2352 x 1568 pixels: 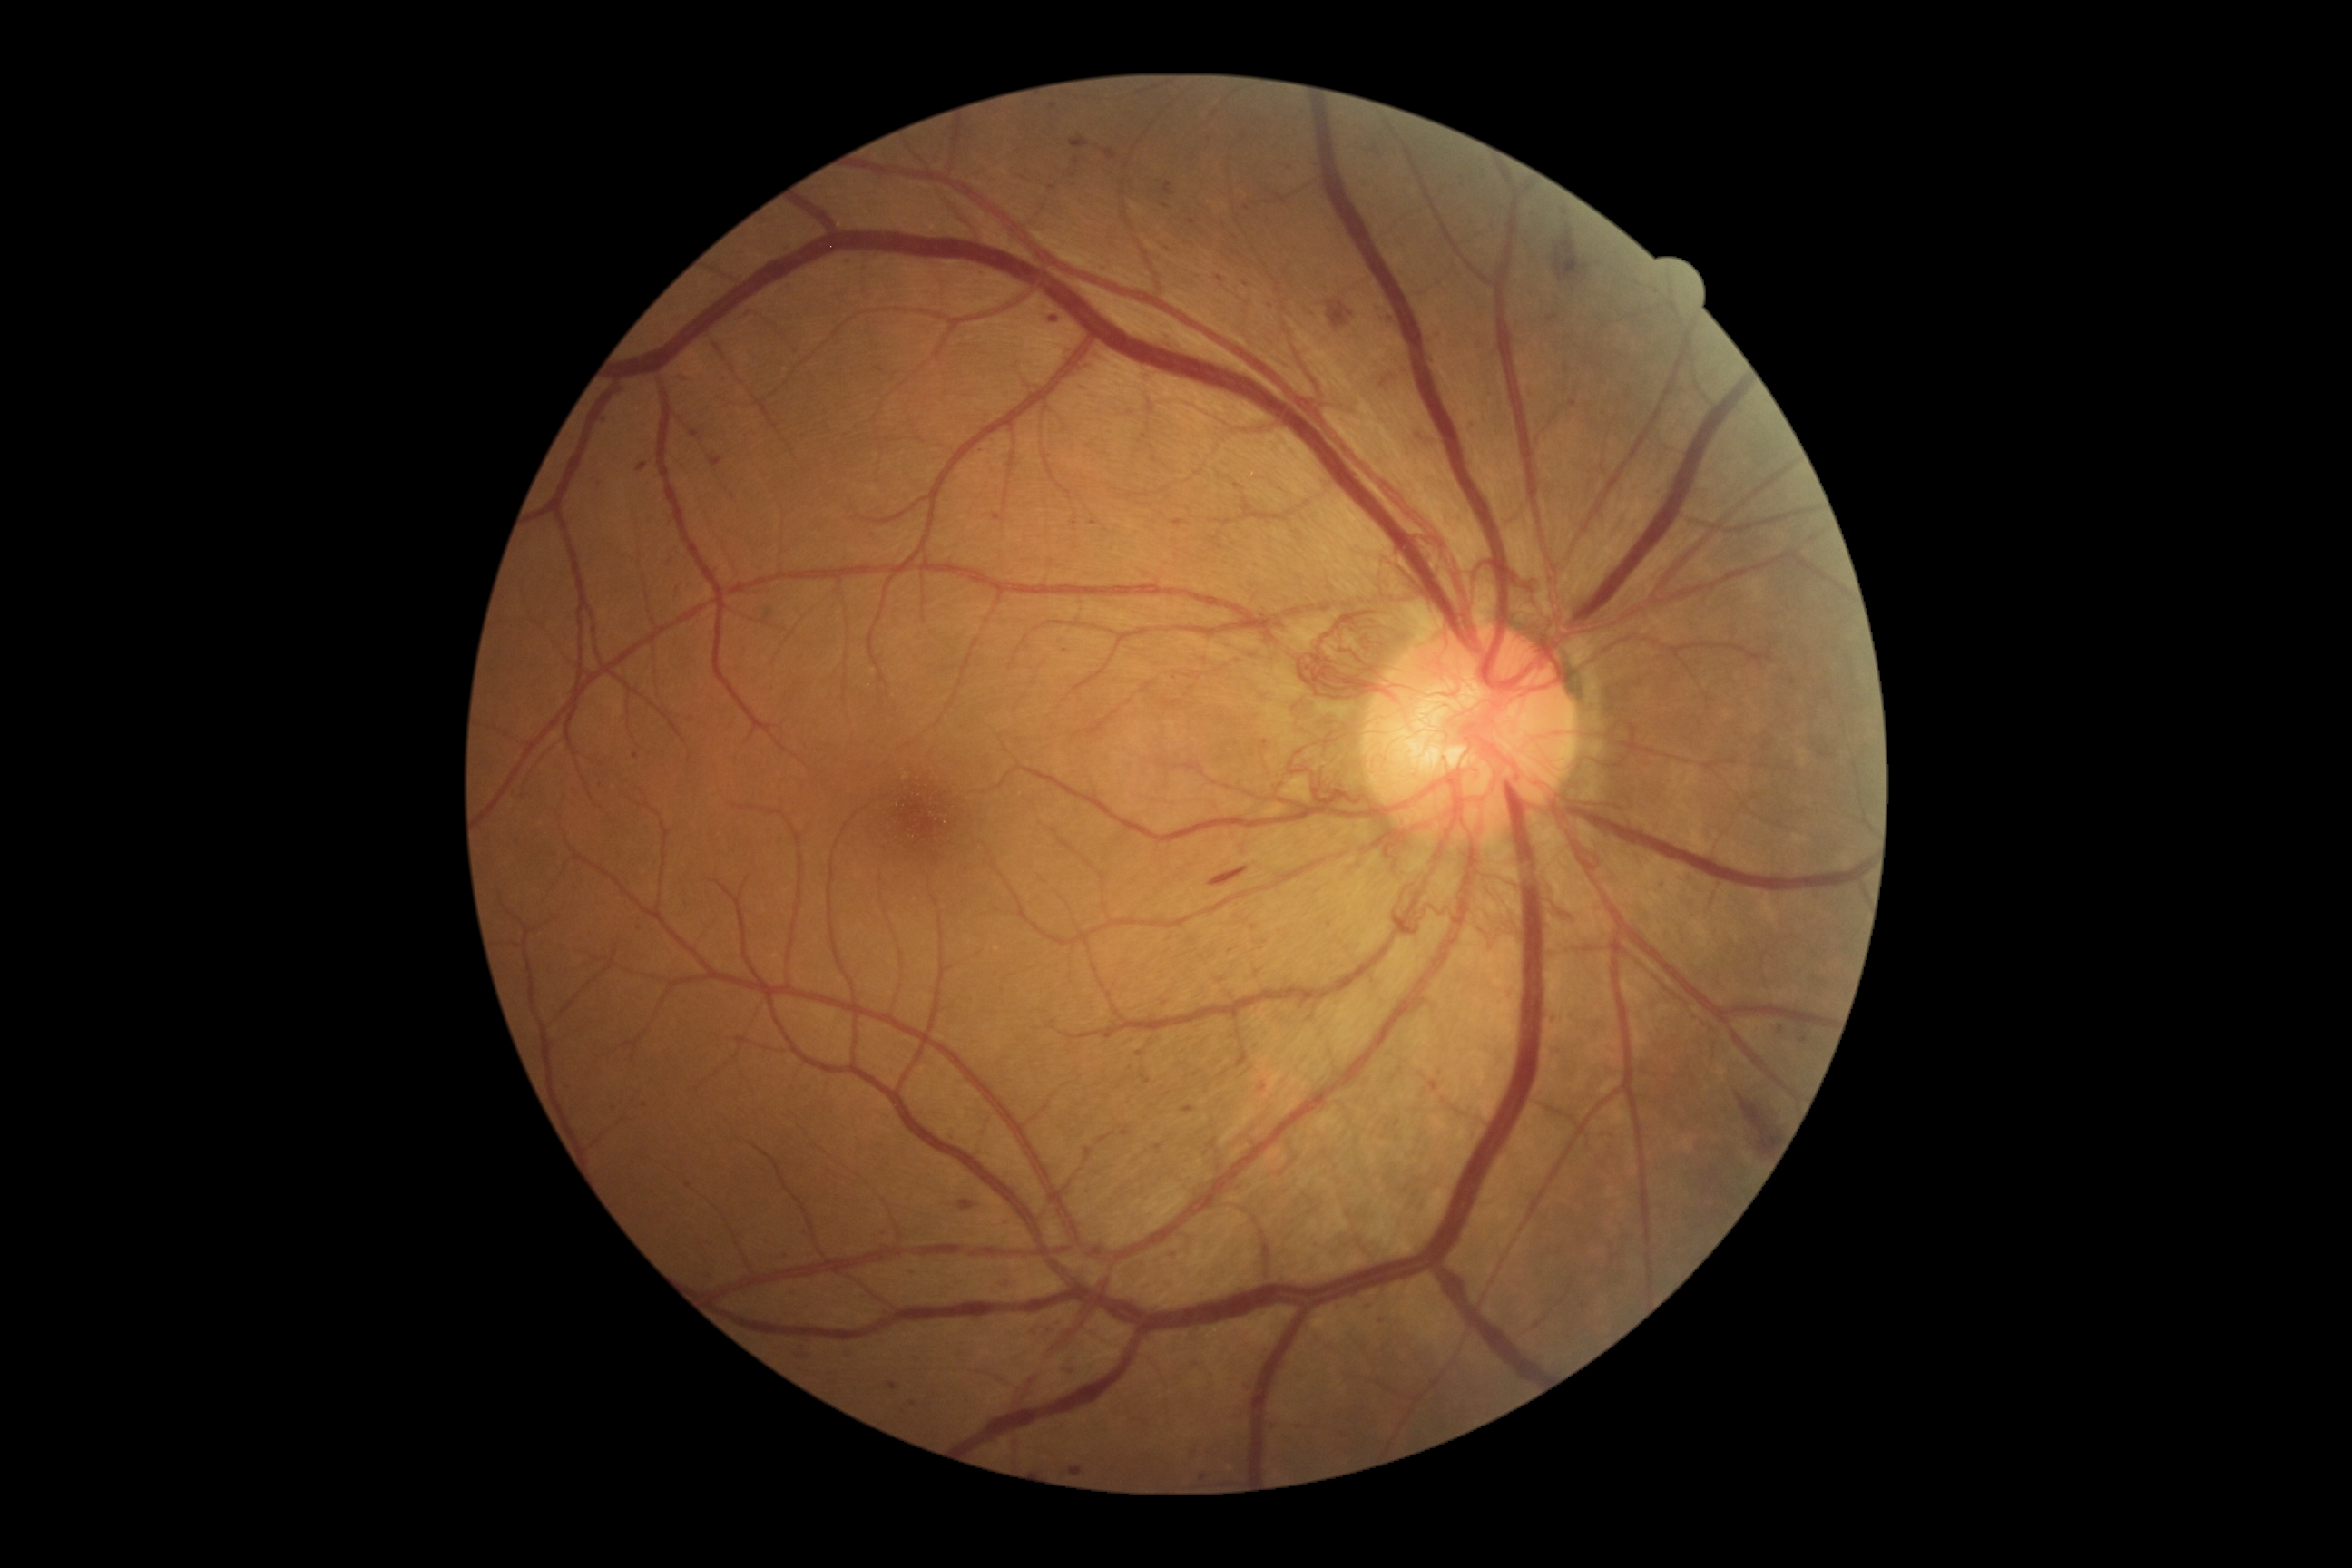
Diabetic retinopathy grade is 4 (PDR)
Selected lesions:
microaneurysms (more not shown) = x1=888 y1=1382 x2=899 y2=1391 | x1=1170 y1=1251 x2=1175 y2=1259 | x1=1188 y1=220 x2=1197 y2=226 | x1=565 y1=1086 x2=574 y2=1090 | x1=1387 y1=317 x2=1395 y2=322 | x1=1469 y1=418 x2=1476 y2=427 | x1=1173 y1=520 x2=1186 y2=527 | x1=990 y1=514 x2=999 y2=522 | x1=1251 y1=926 x2=1259 y2=930
Microaneurysms (small, approximate centers) near point(1370, 1303) | point(1203, 1479) | point(1007, 1283) | point(788, 247) | point(1053, 107) | point(1440, 1074) | point(1574, 403) | point(1081, 385) | point(885, 1235) | point(982, 271)